45° field of view · 2352 x 1568 pixels
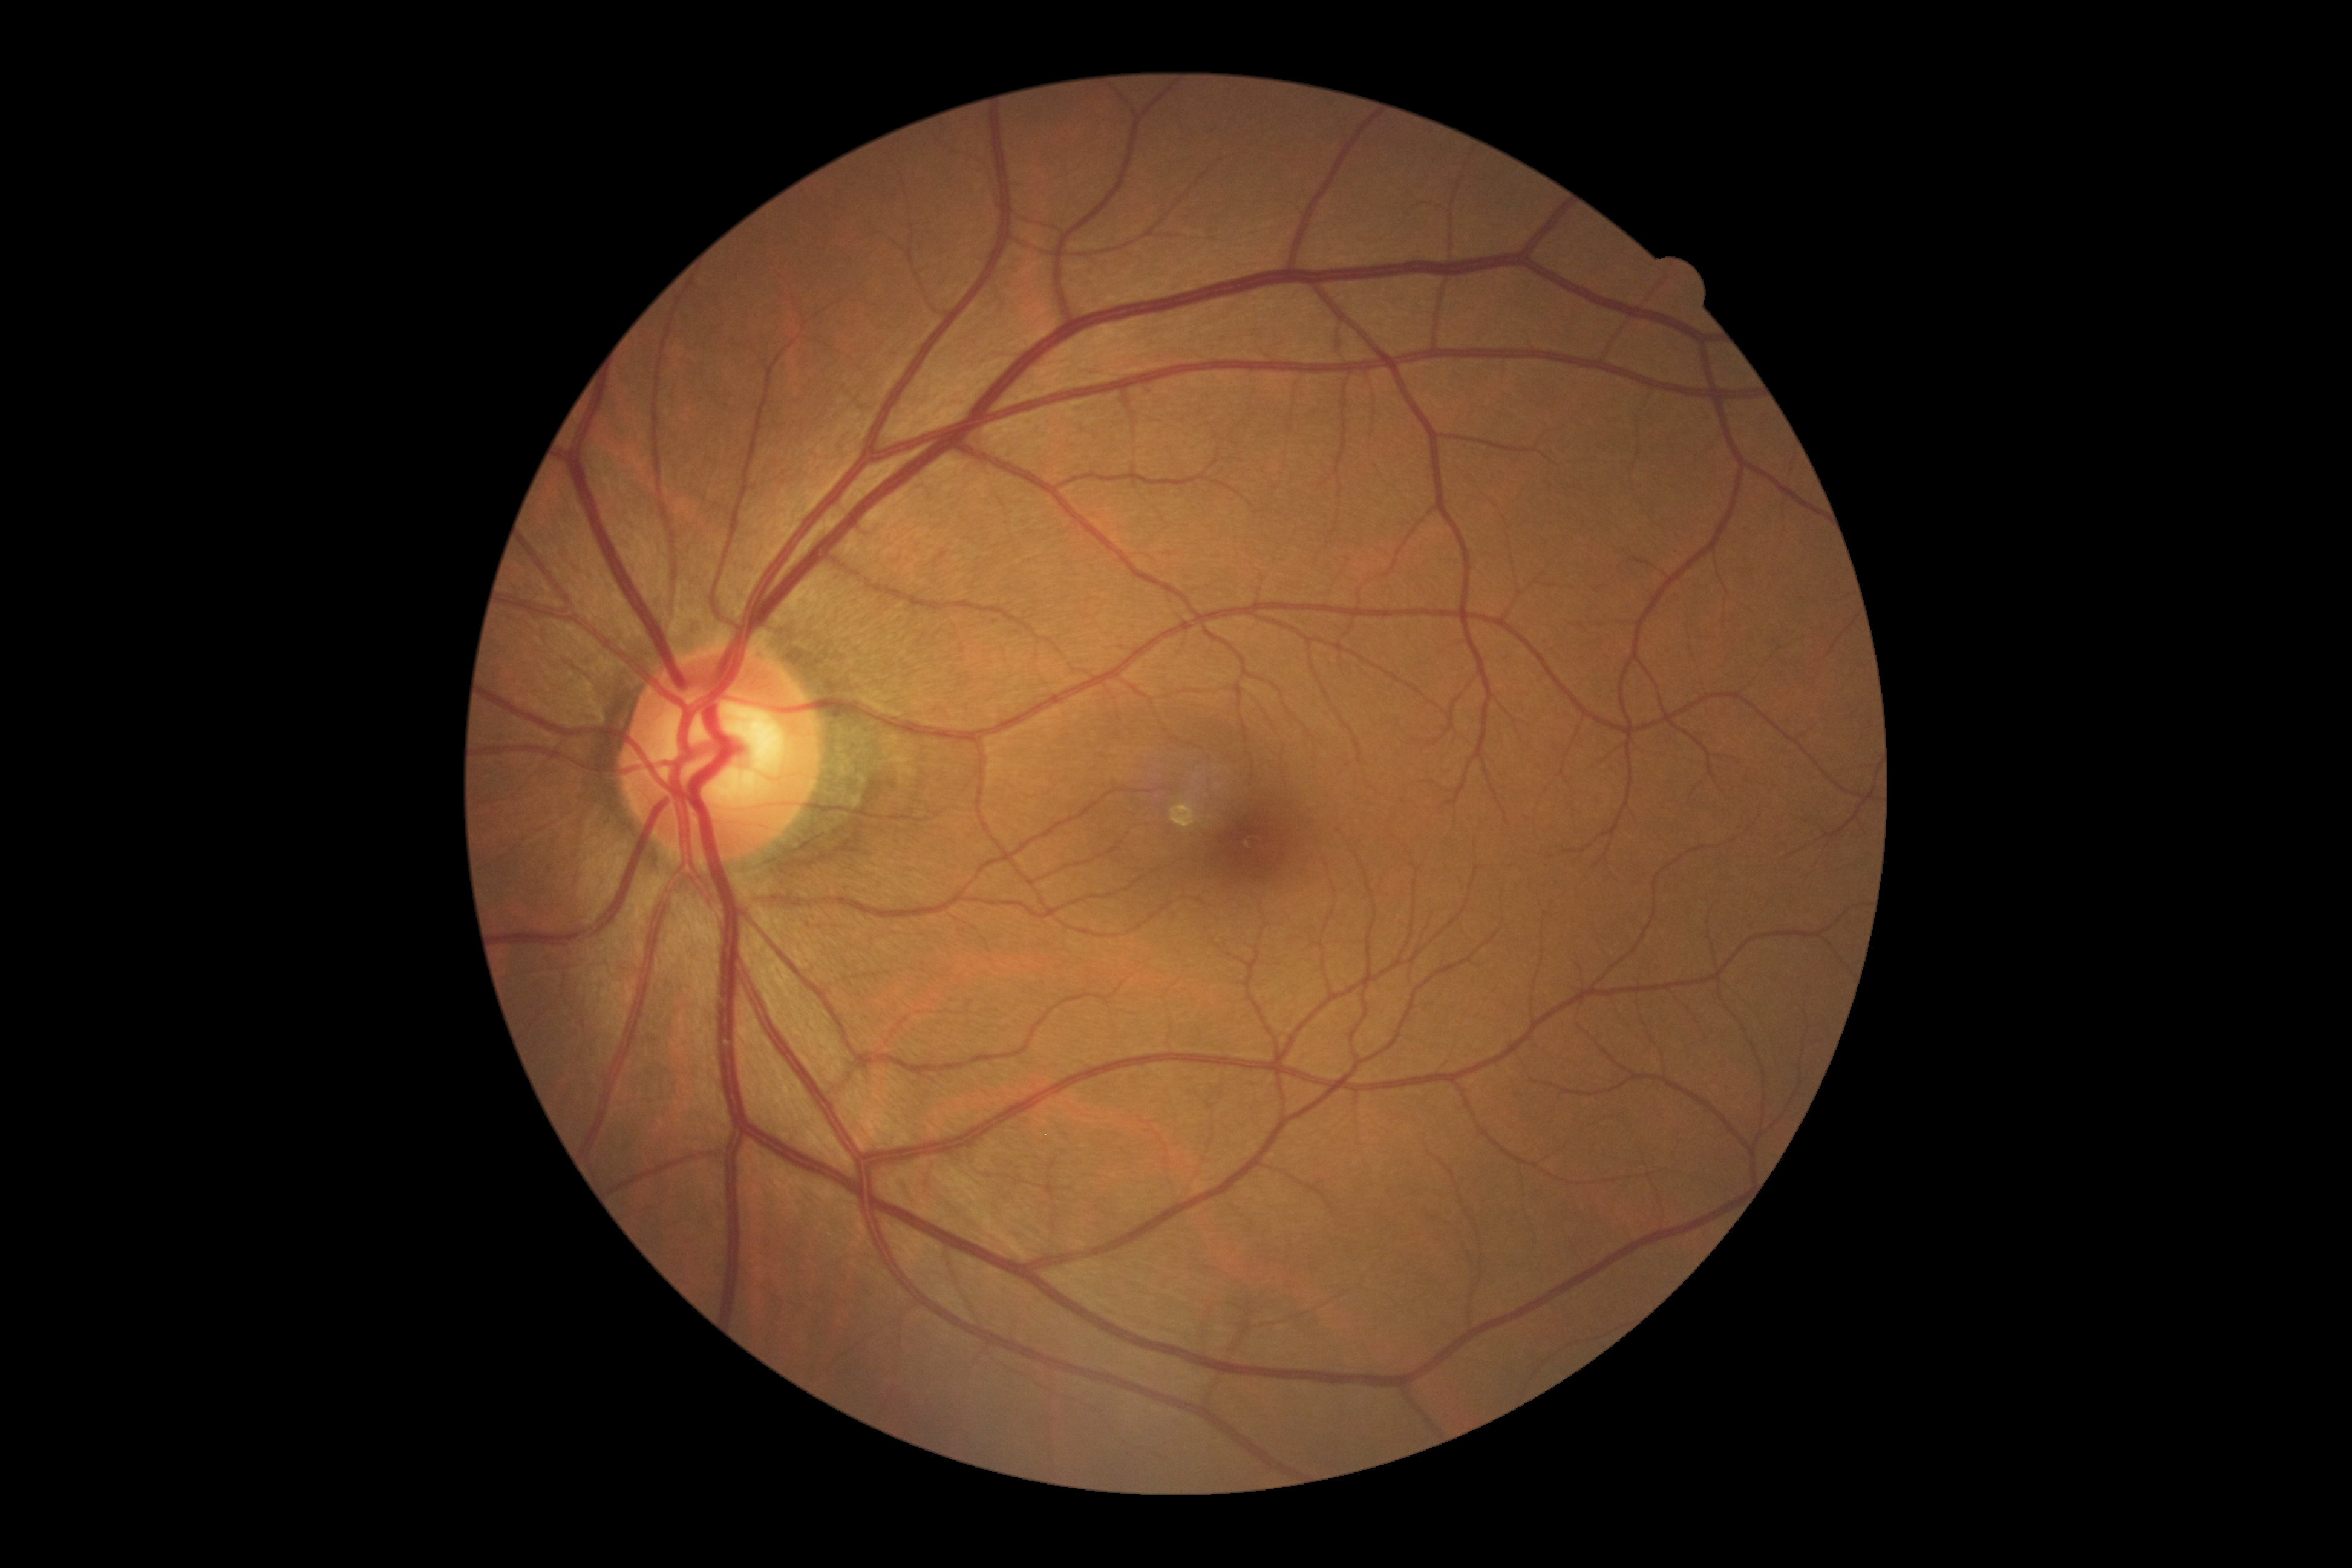 Retinopathy is grade 0.